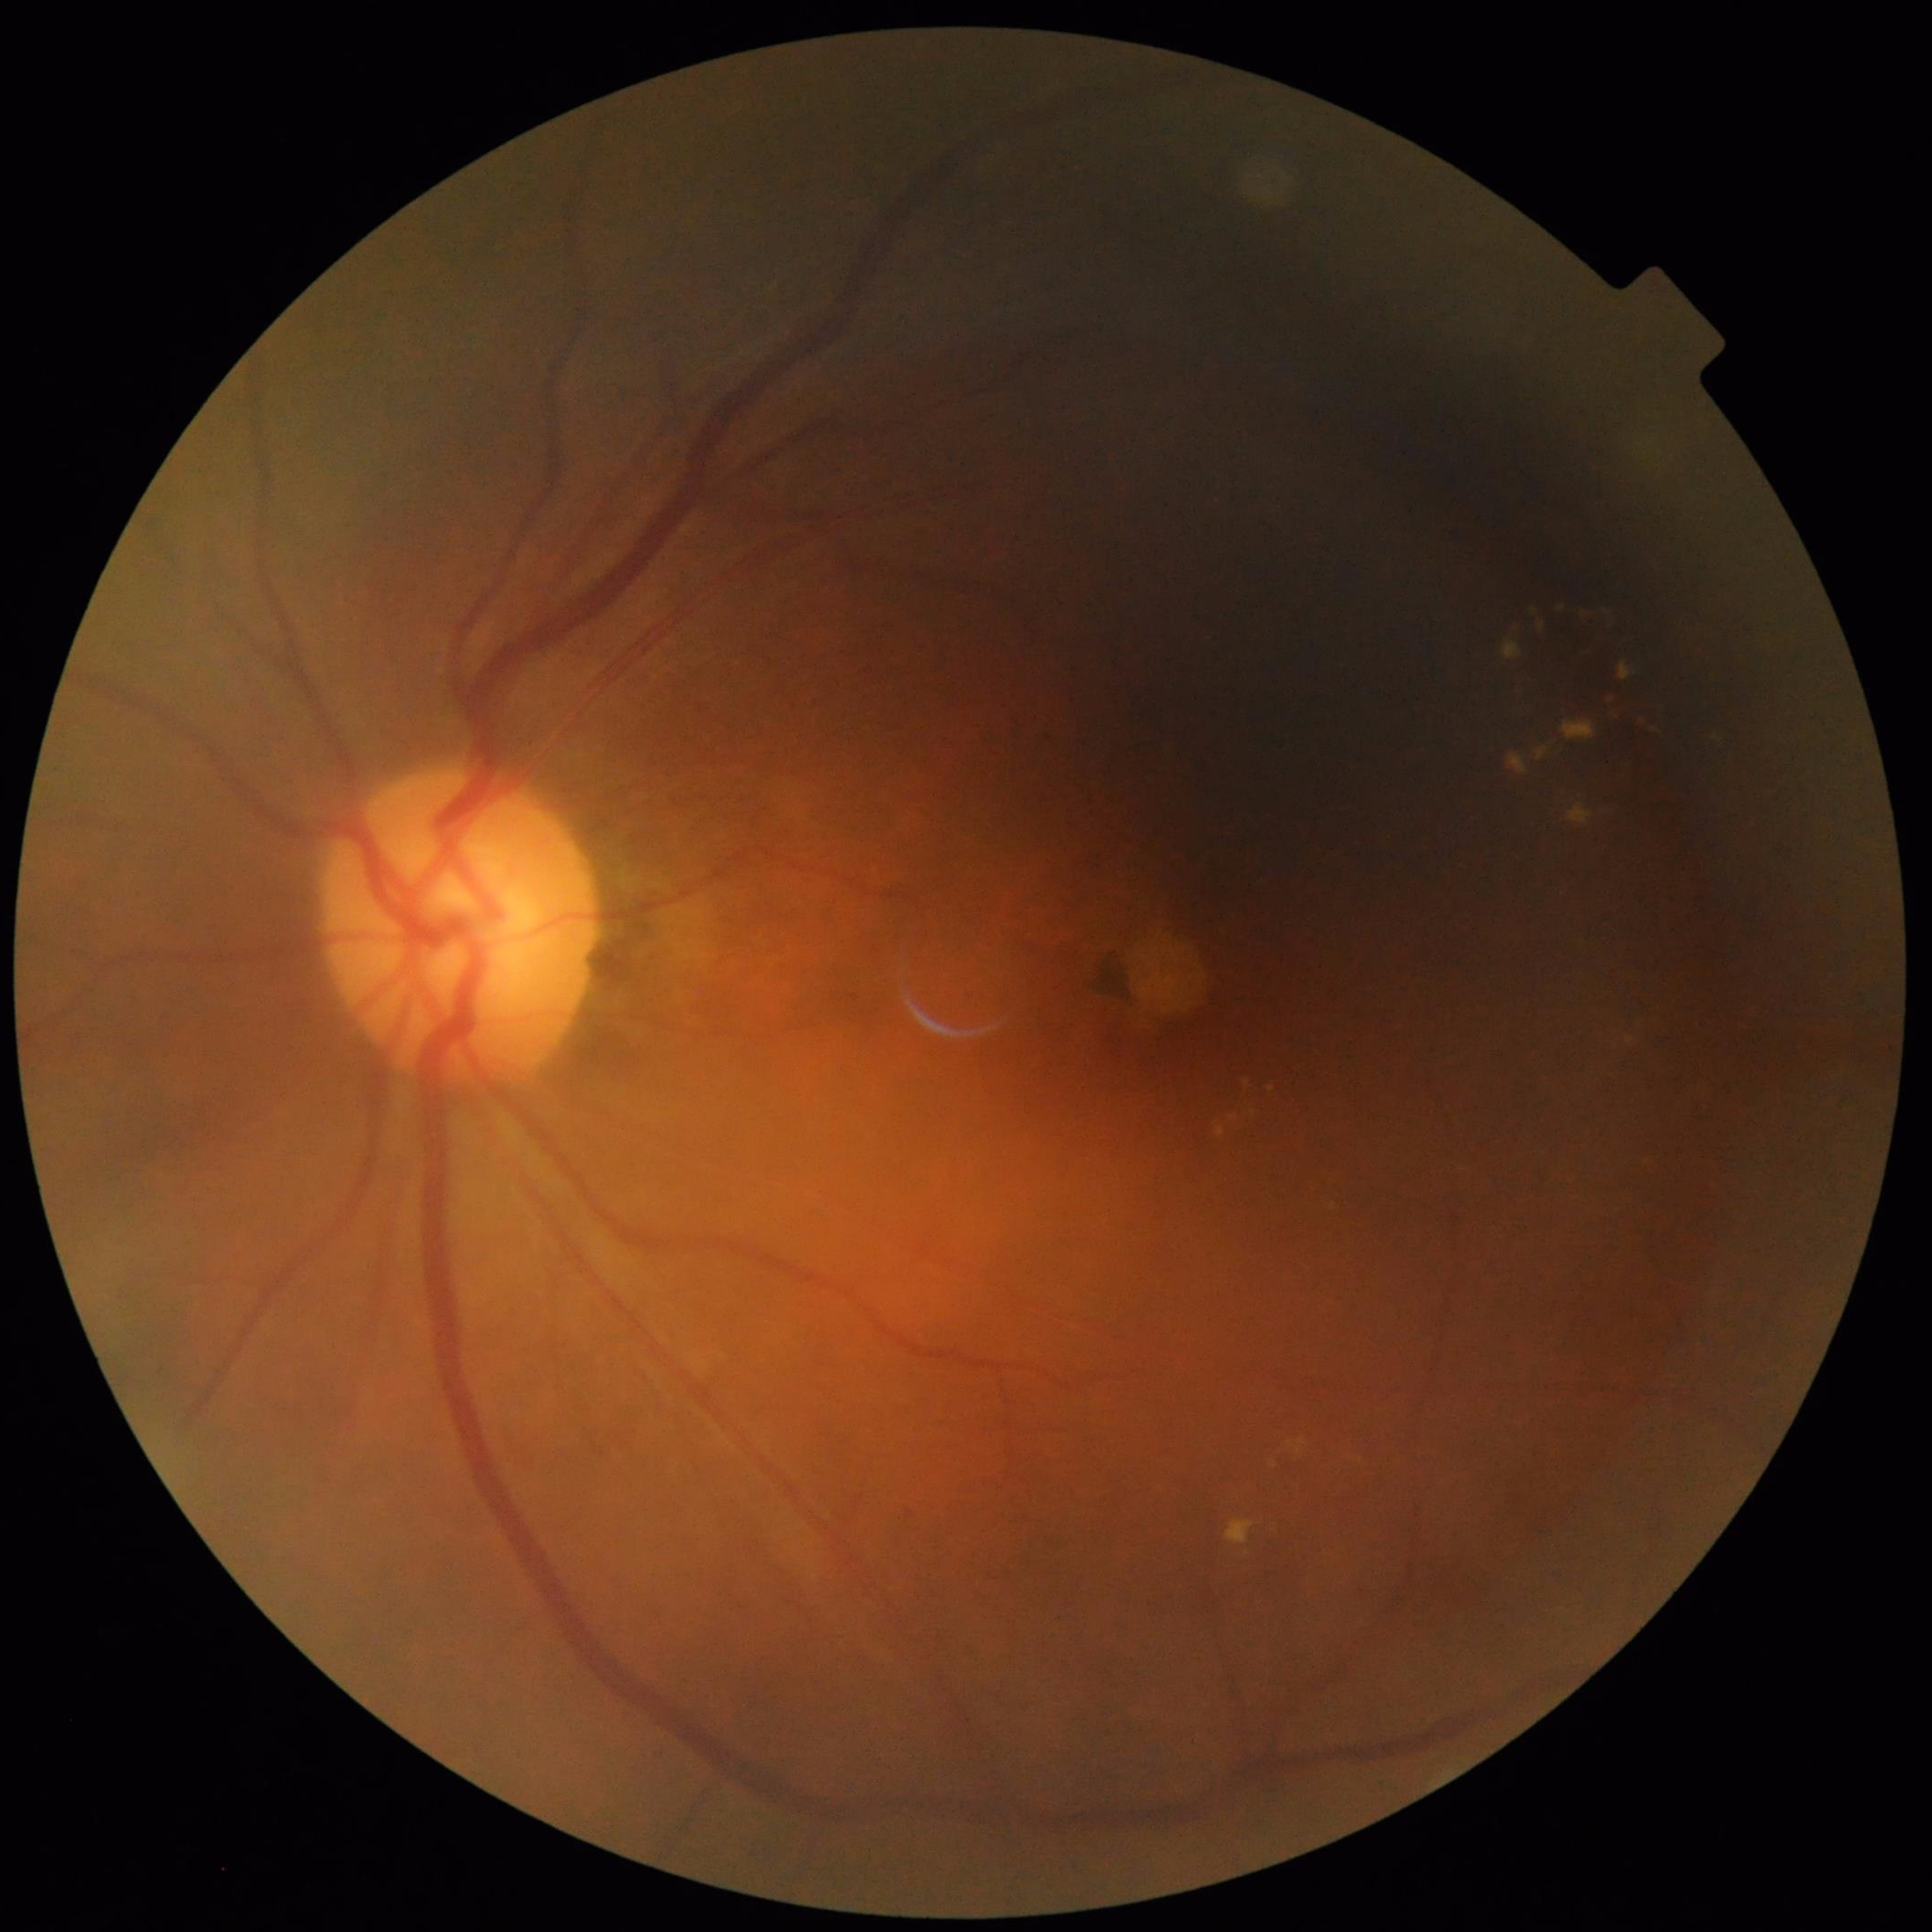 Photo quality: reduced — illumination/color distortion, blur. Patient diagnosed with diabetic retinopathy.